Davis DR grading. Color fundus photograph. 848x848:
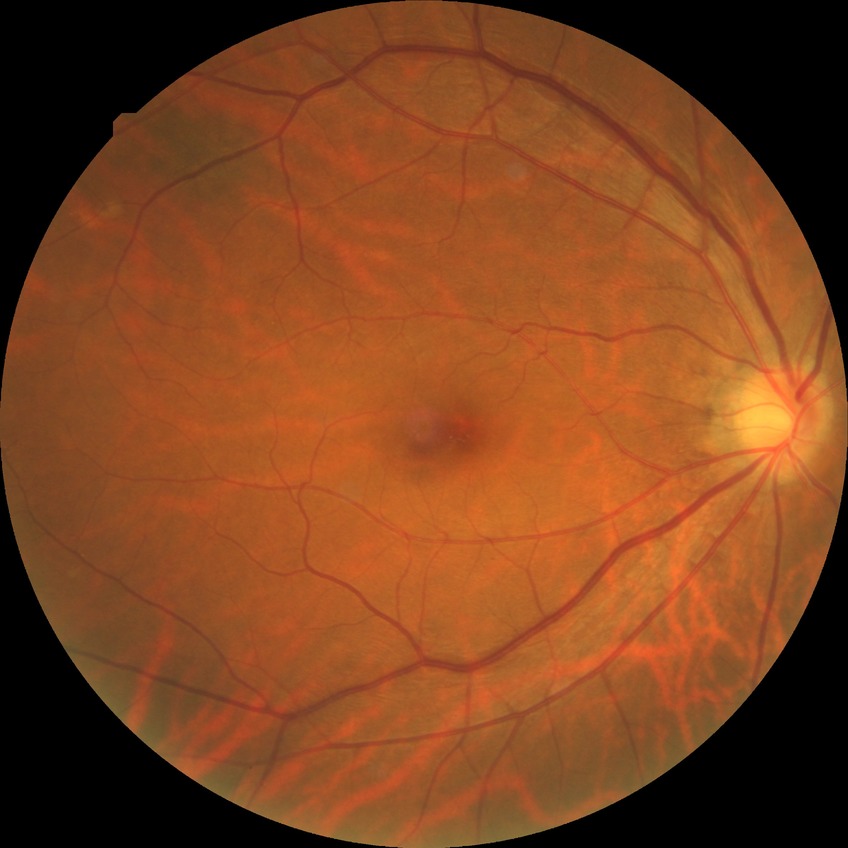 Diabetic retinopathy (DR): NDR (no diabetic retinopathy).